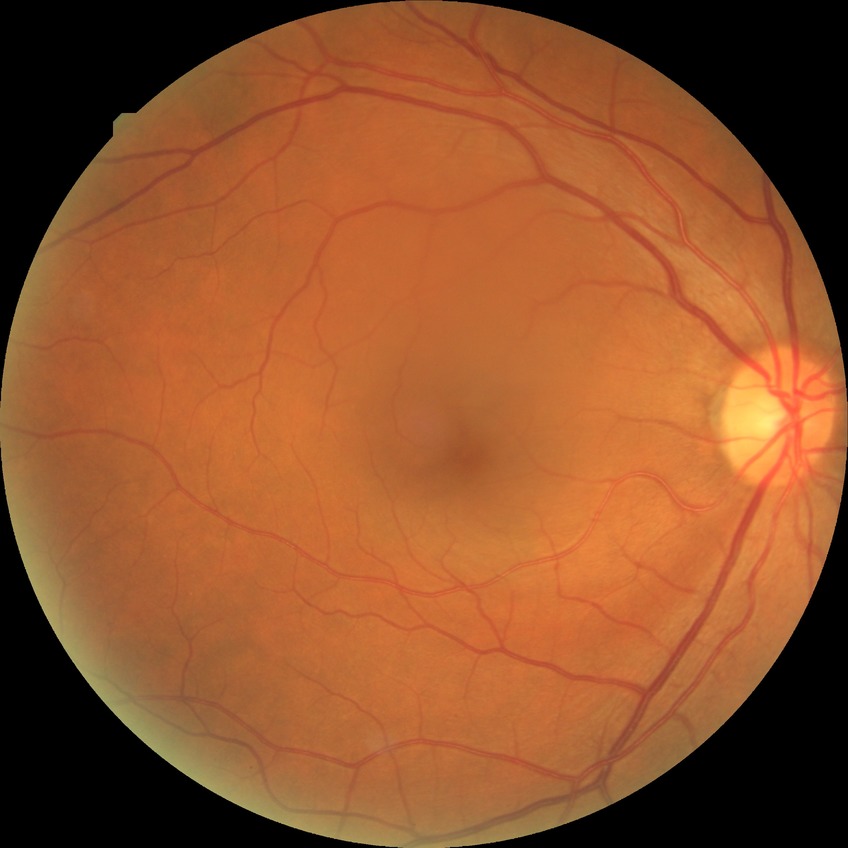

Findings:
- Davis grading — simple diabetic retinopathy